Nonmydriatic fundus photograph: 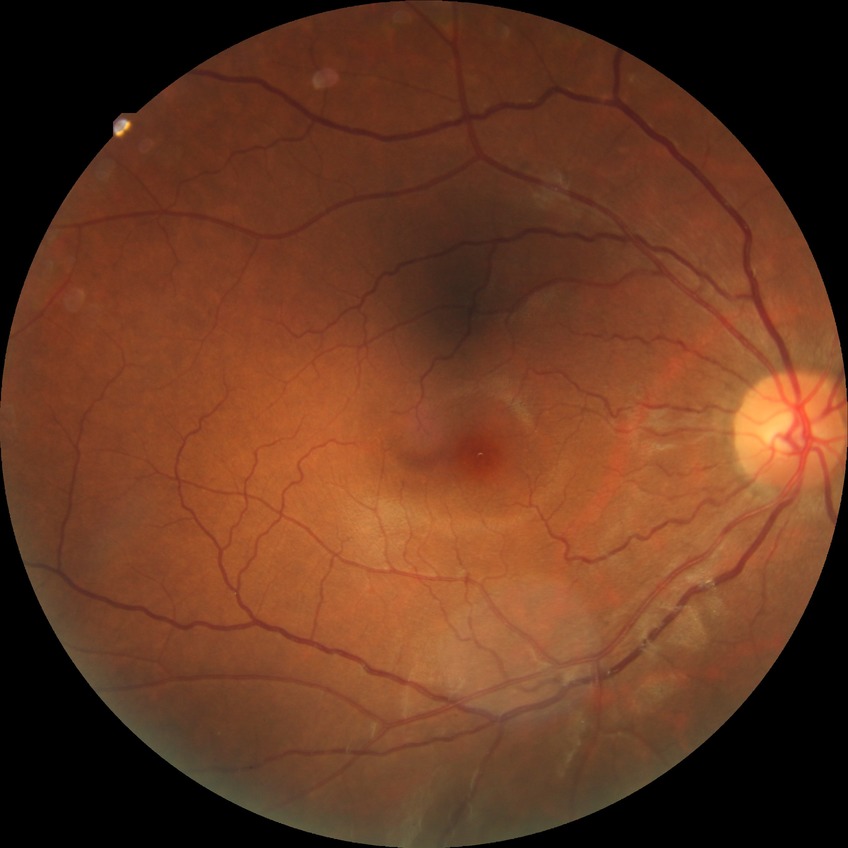

diabetic retinopathy (DR)=NDR (no diabetic retinopathy).